Infant wide-field fundus photograph: 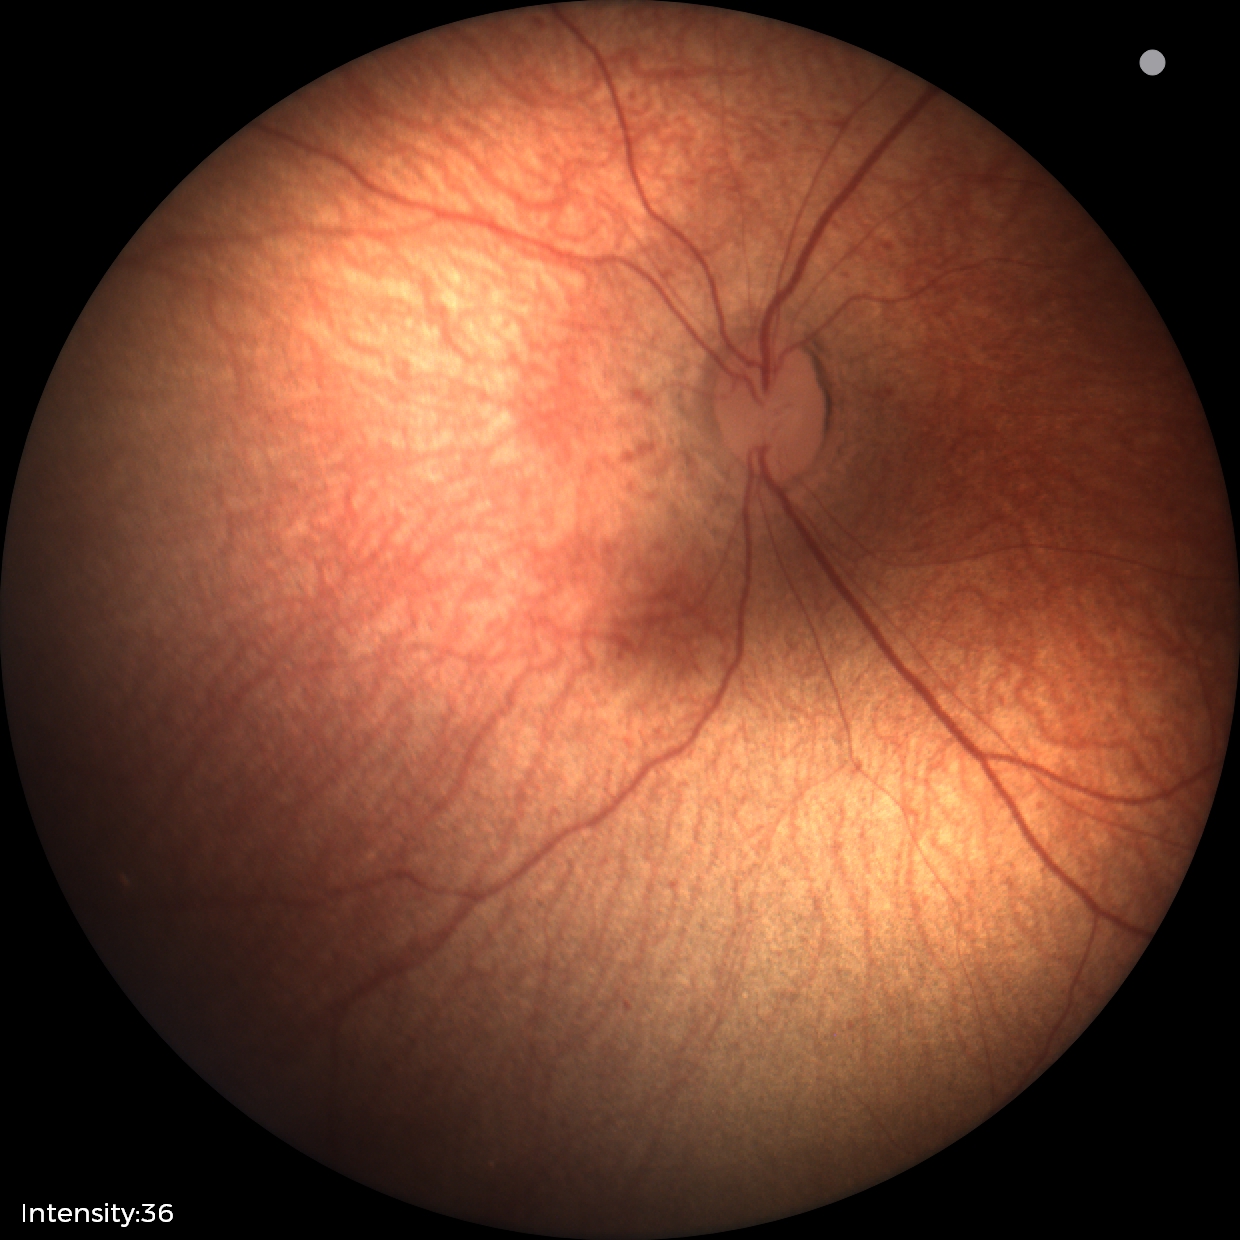
Examination with physiological retinal findings.